2048 x 1536 pixels:
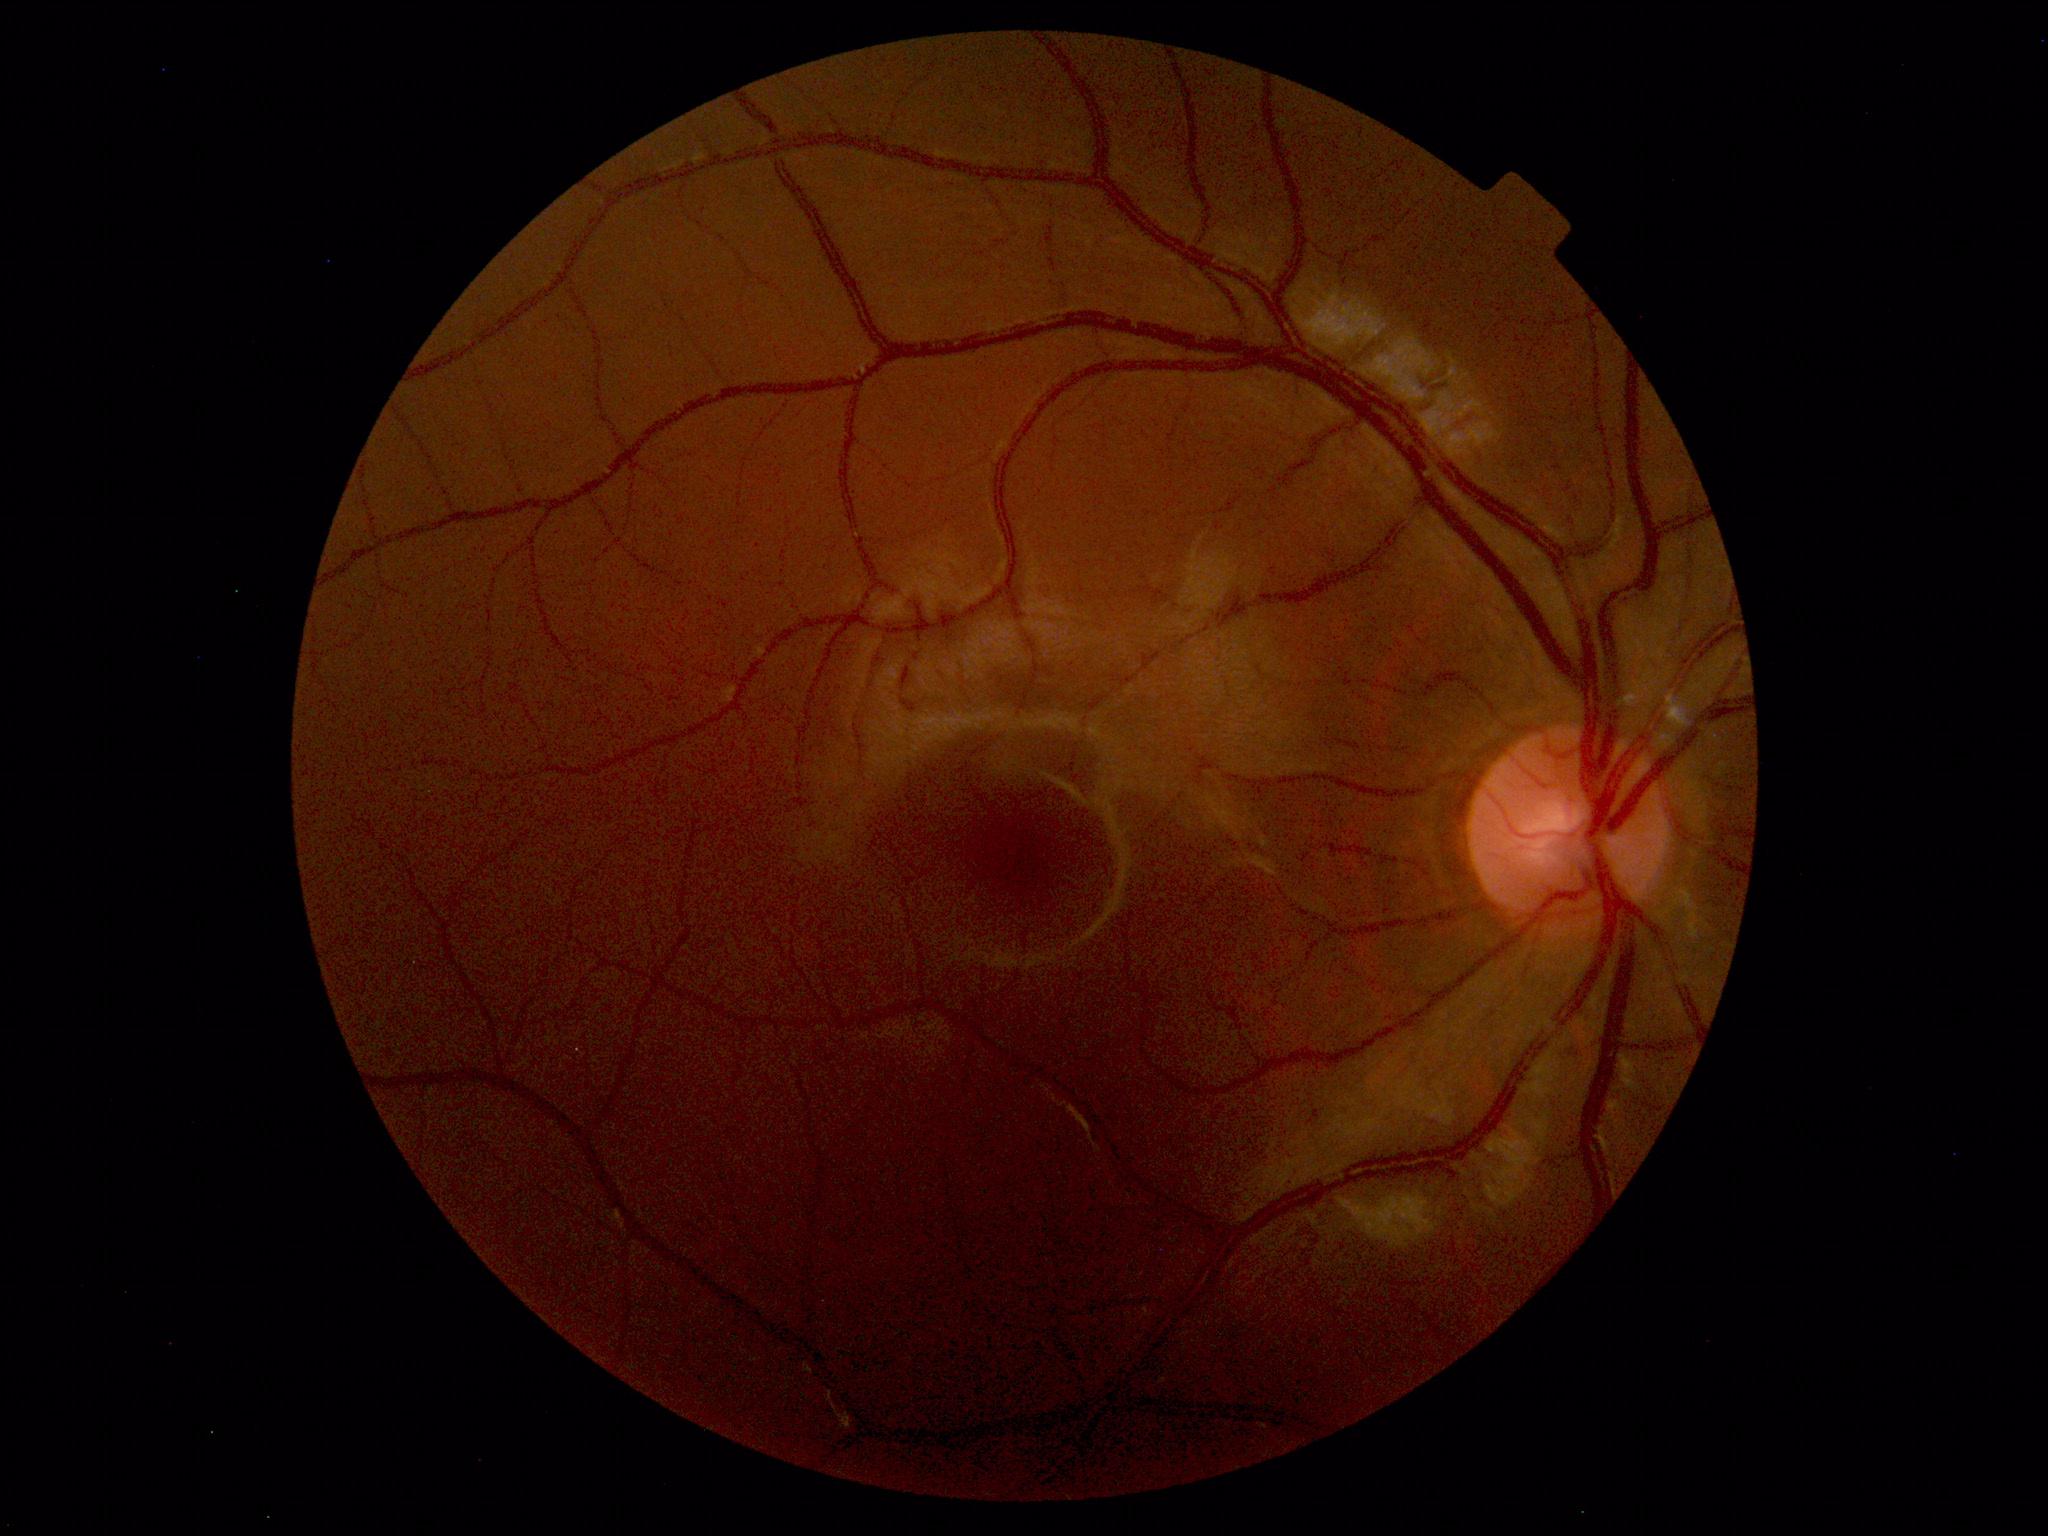
Unremarkable color fundus photograph.